Graded on the modified Davis scale · no pharmacologic dilation · FOV: 45 degrees — 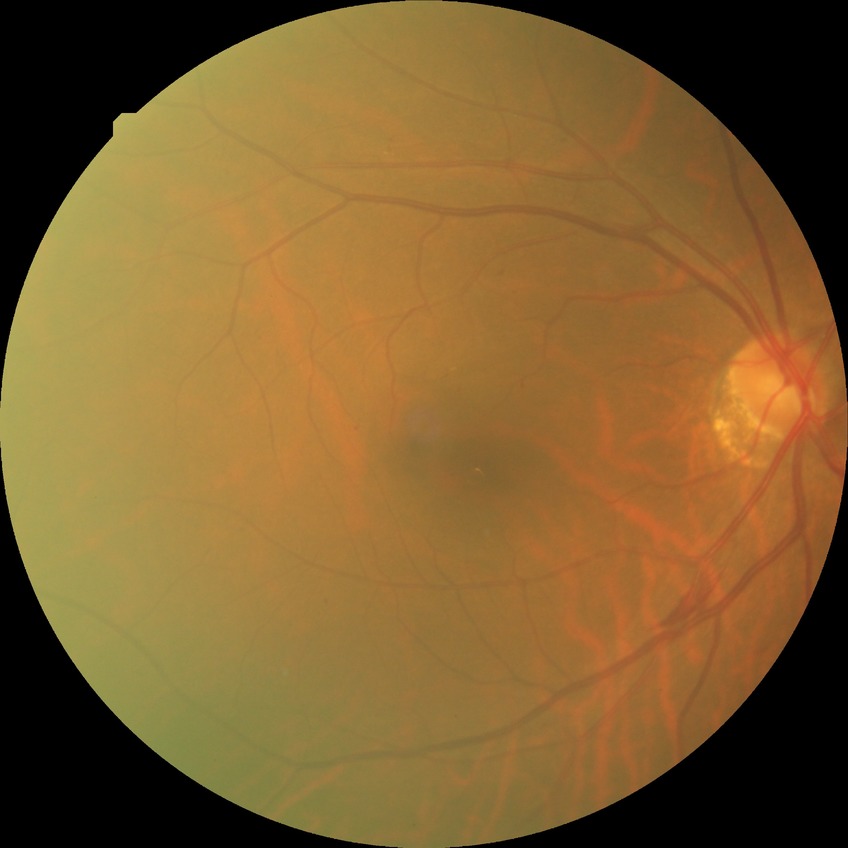

DR class: non-proliferative diabetic retinopathy.
Davis grade: SDR.